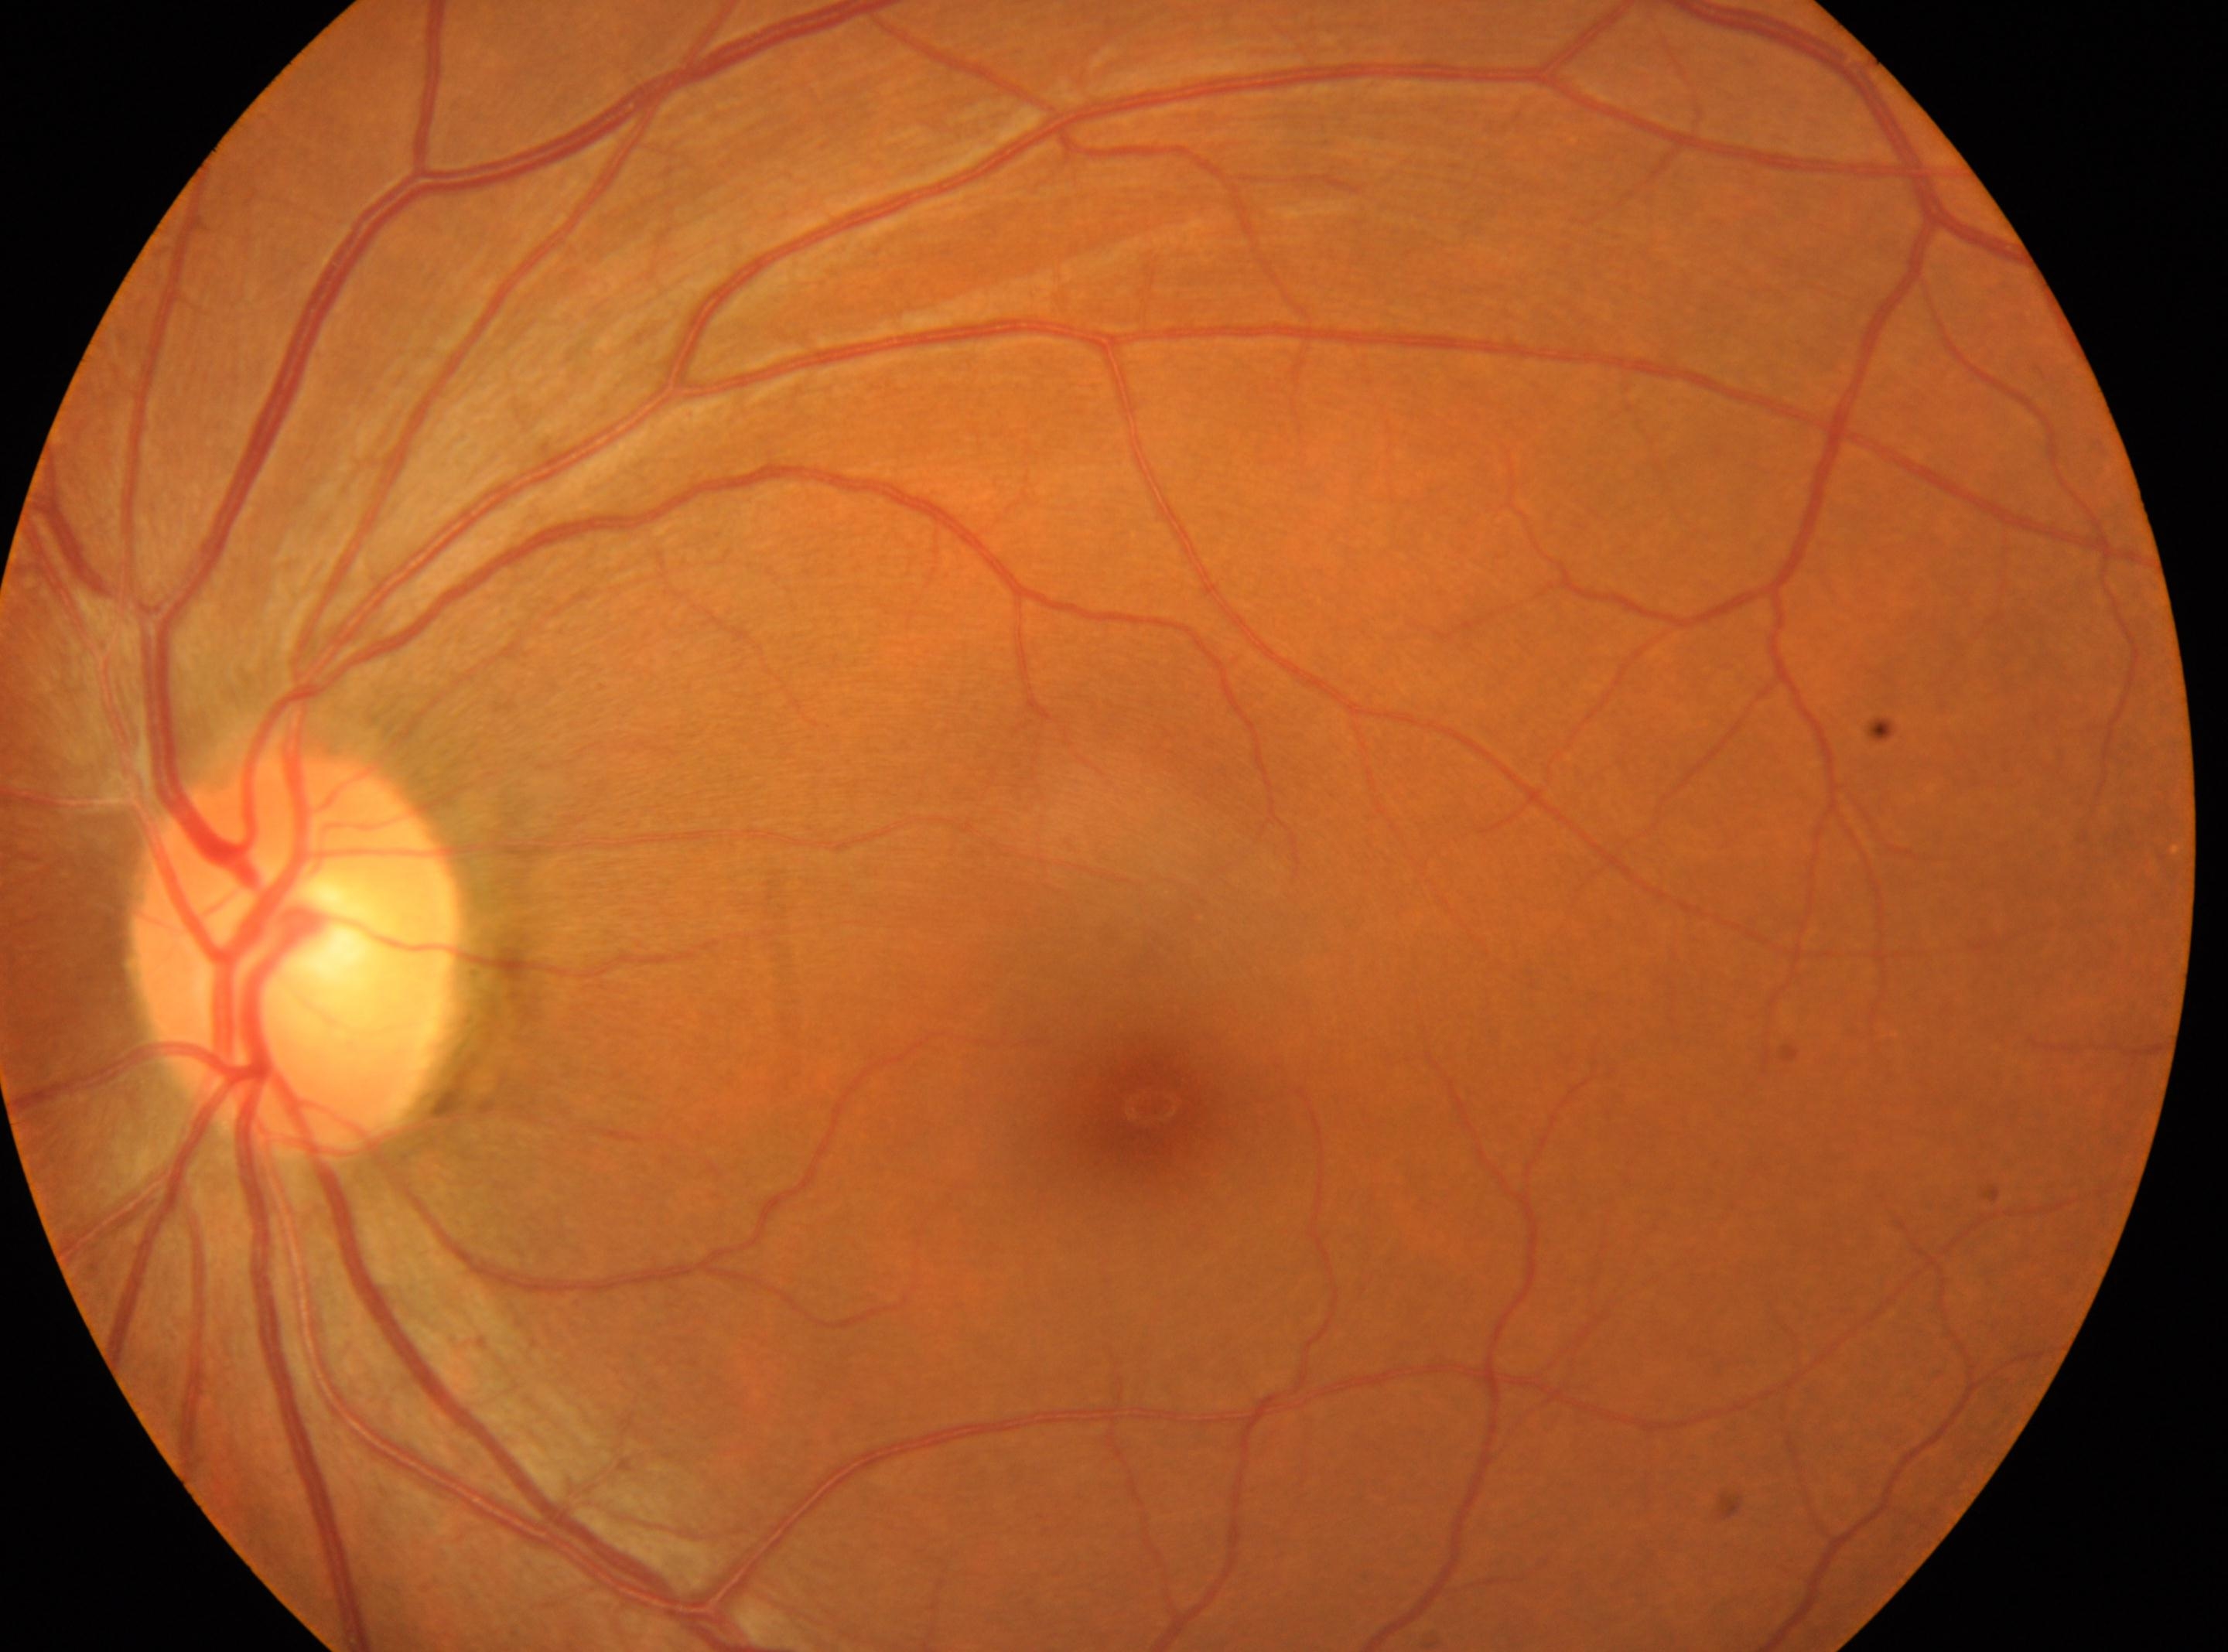 The fovea is at (x: 1150, y: 1106).
ONH: (x: 294, y: 951).
The image shows the OS.
Diabetic retinopathy (DR): 0 — no visible signs of diabetic retinopathy.